Wide-field contact fundus photograph of an infant: 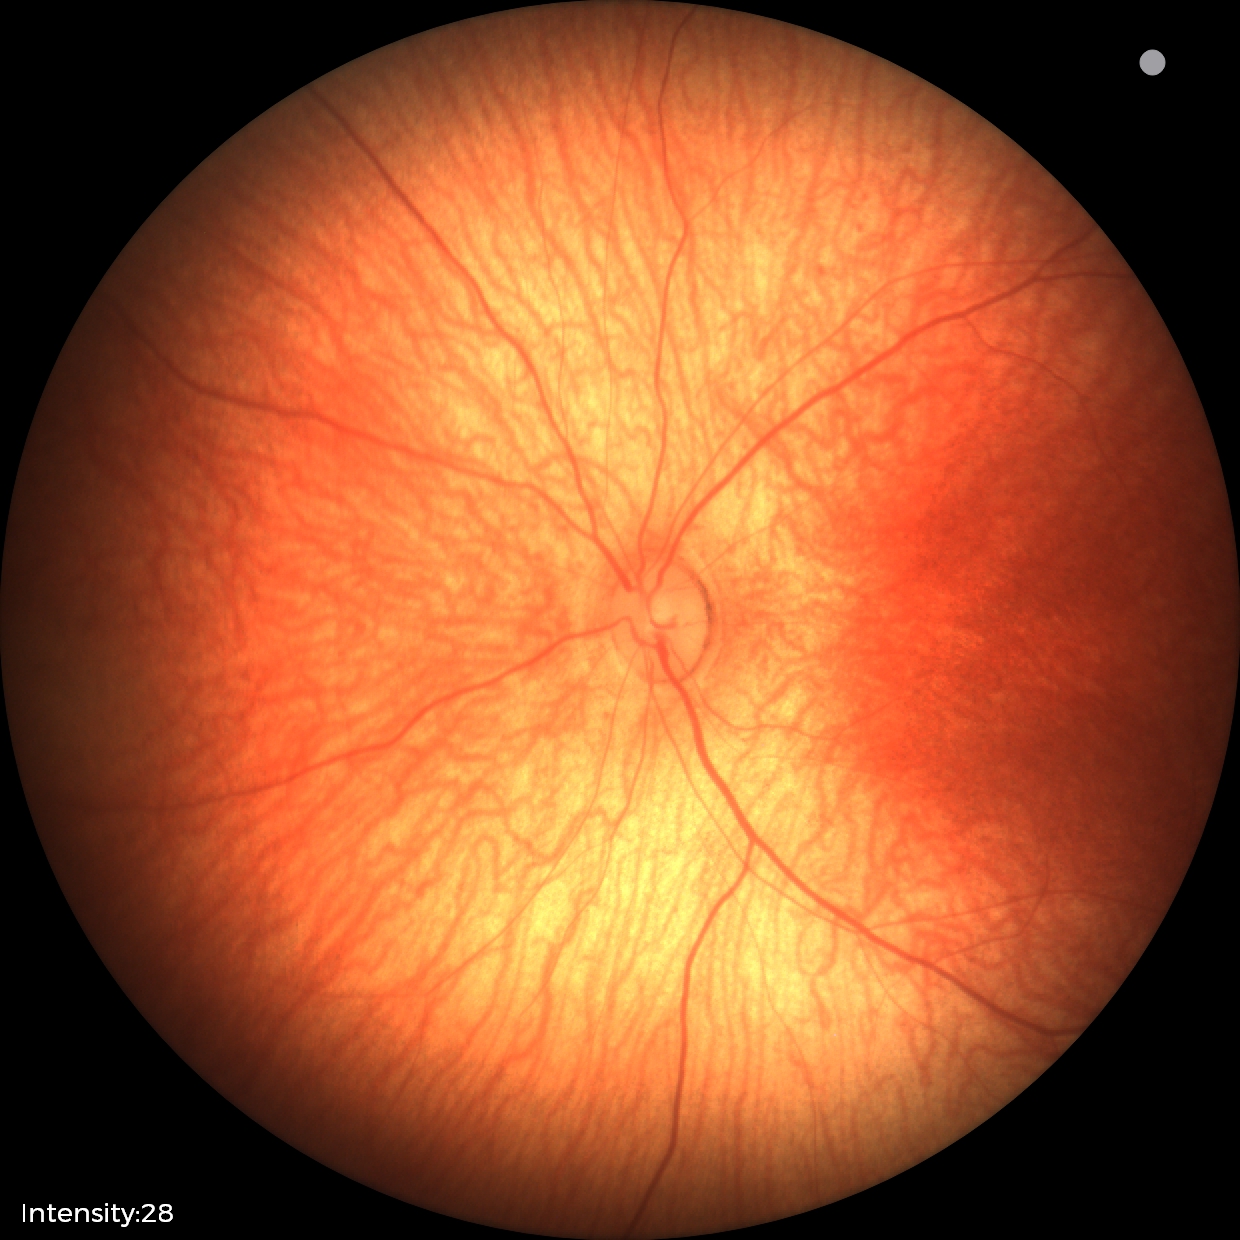

Screening examination with no abnormal retinal findings.